Optic disc-centered crop from a color fundus photograph: 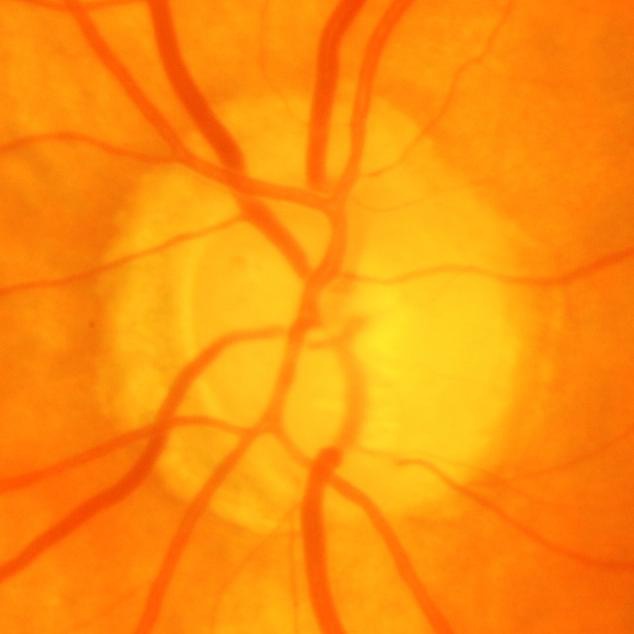
Diagnosis: glaucomatous findings.